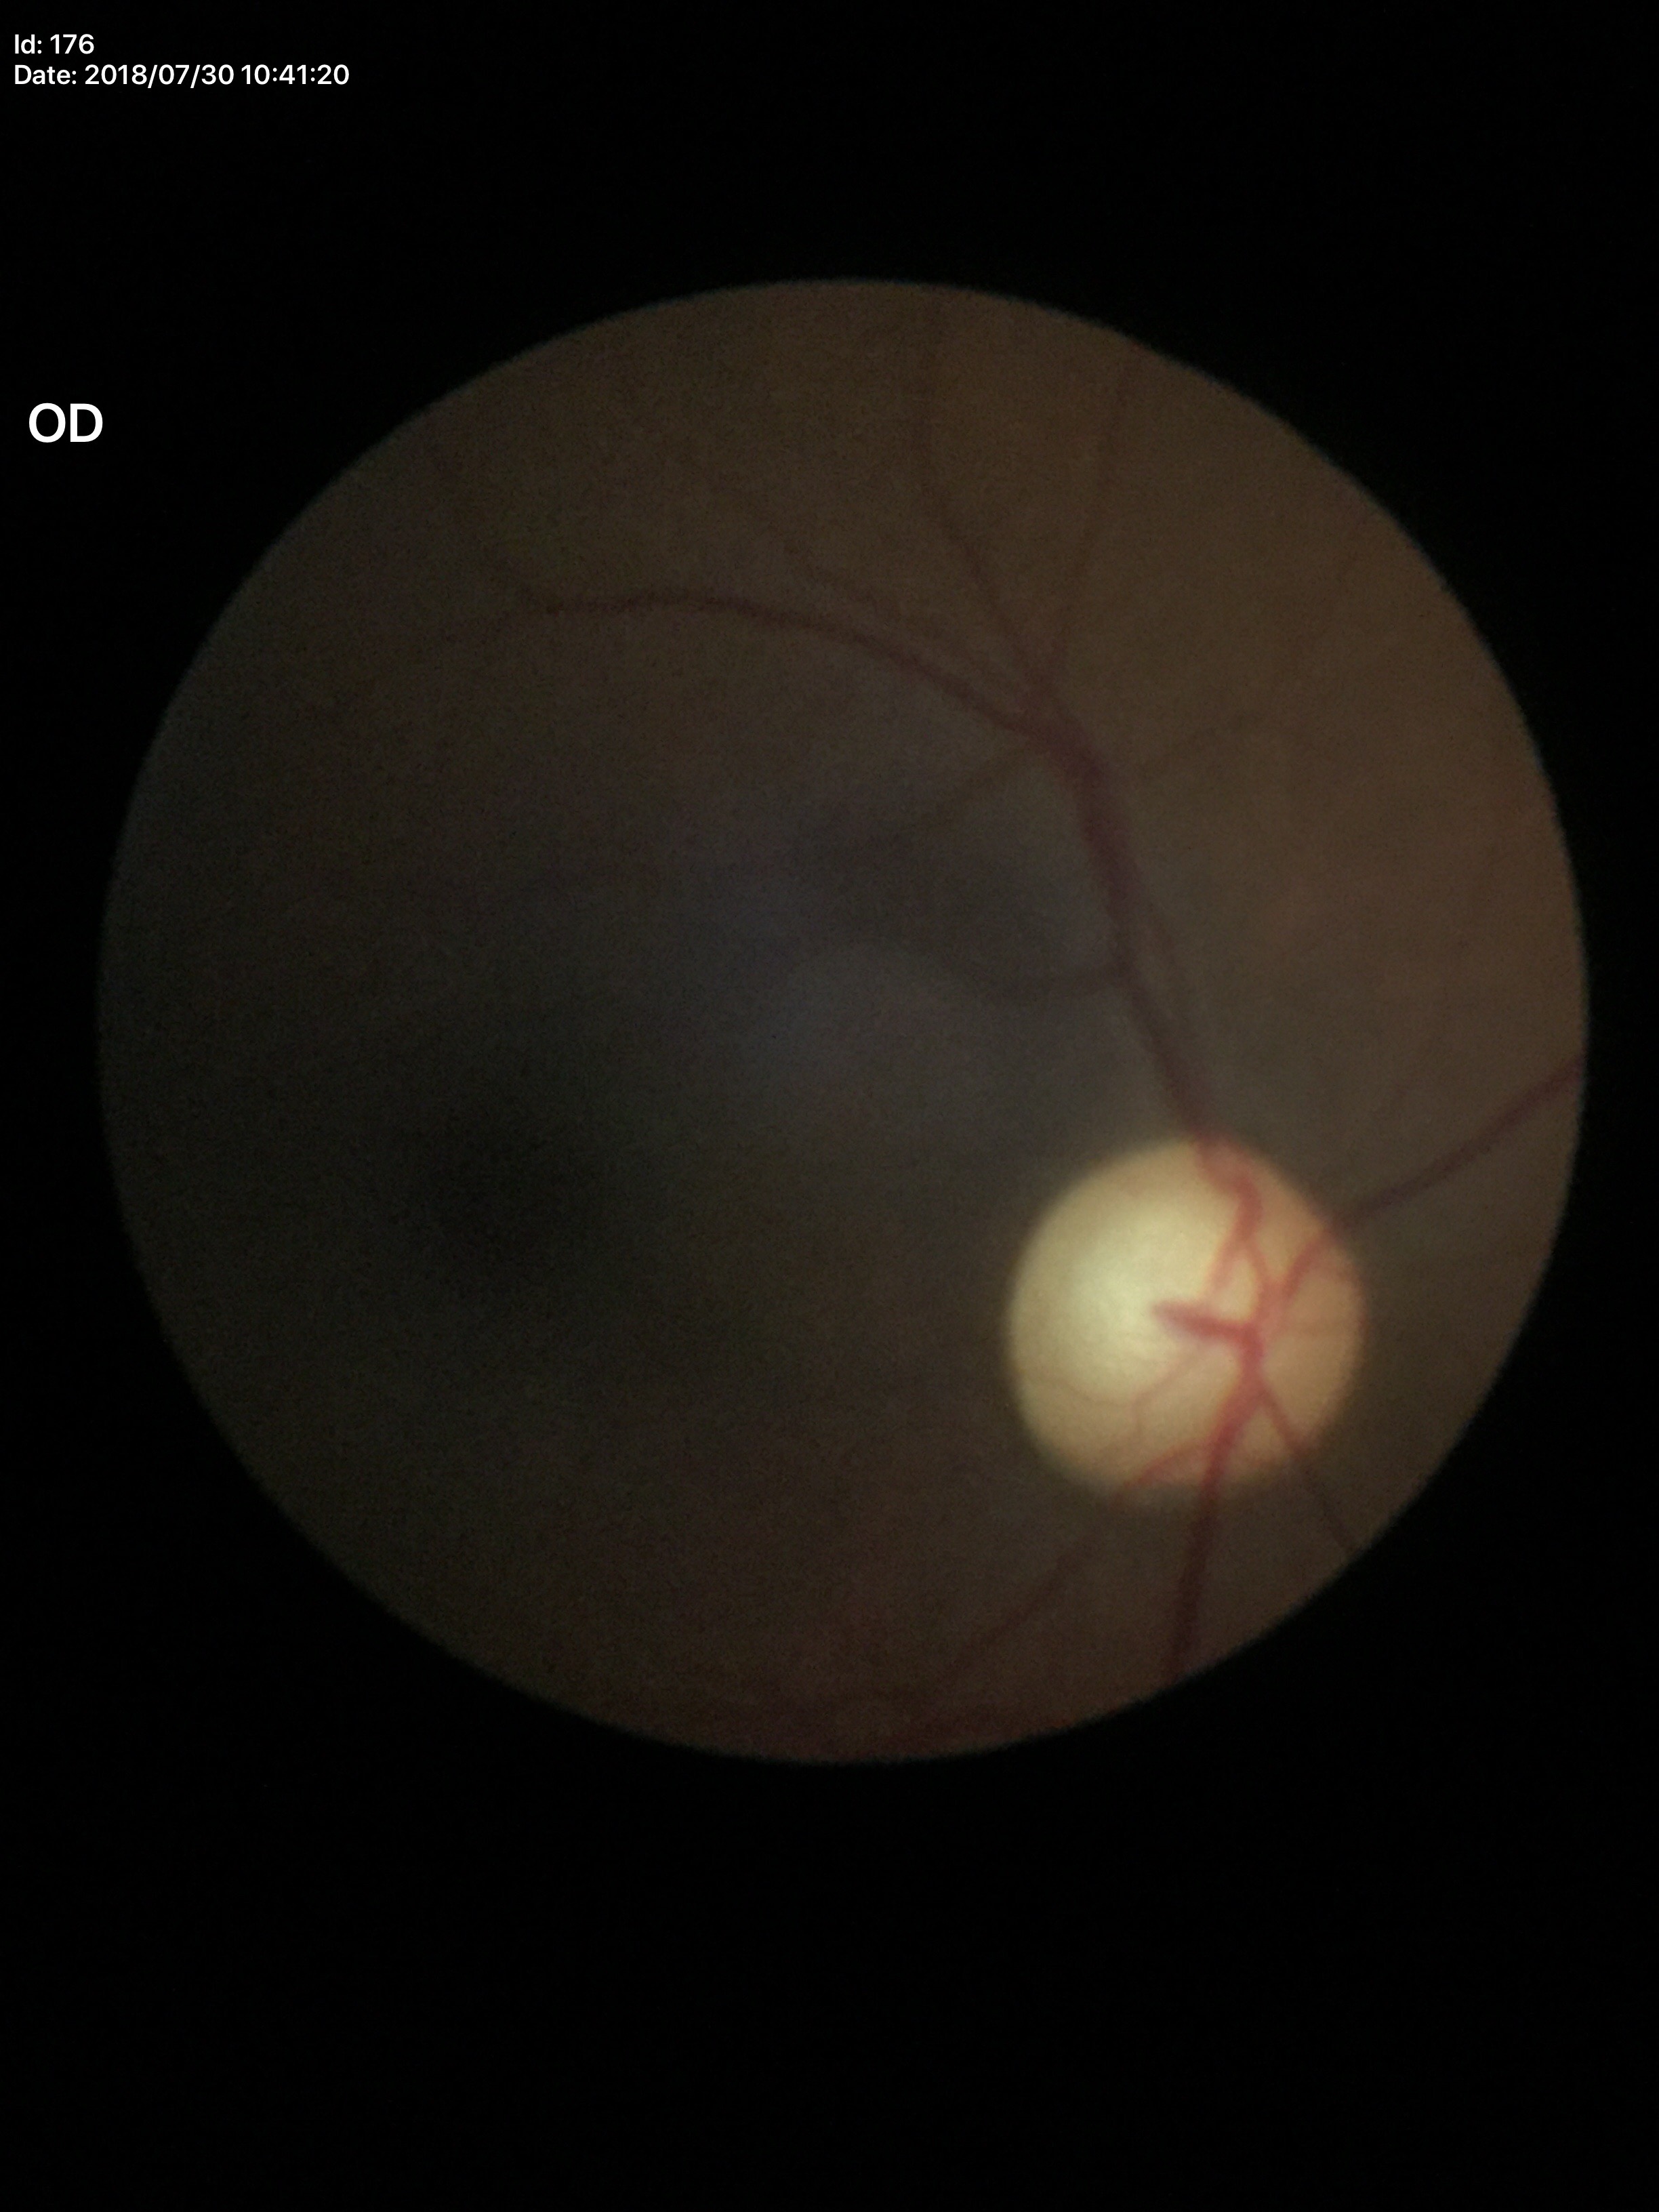
Suspect for glaucomatous optic neuropathy (all 5 graders flagged glaucoma suspect). VCDR is 0.71. ACDR: 0.47. HCDR of 0.65.